FOV: 45 degrees
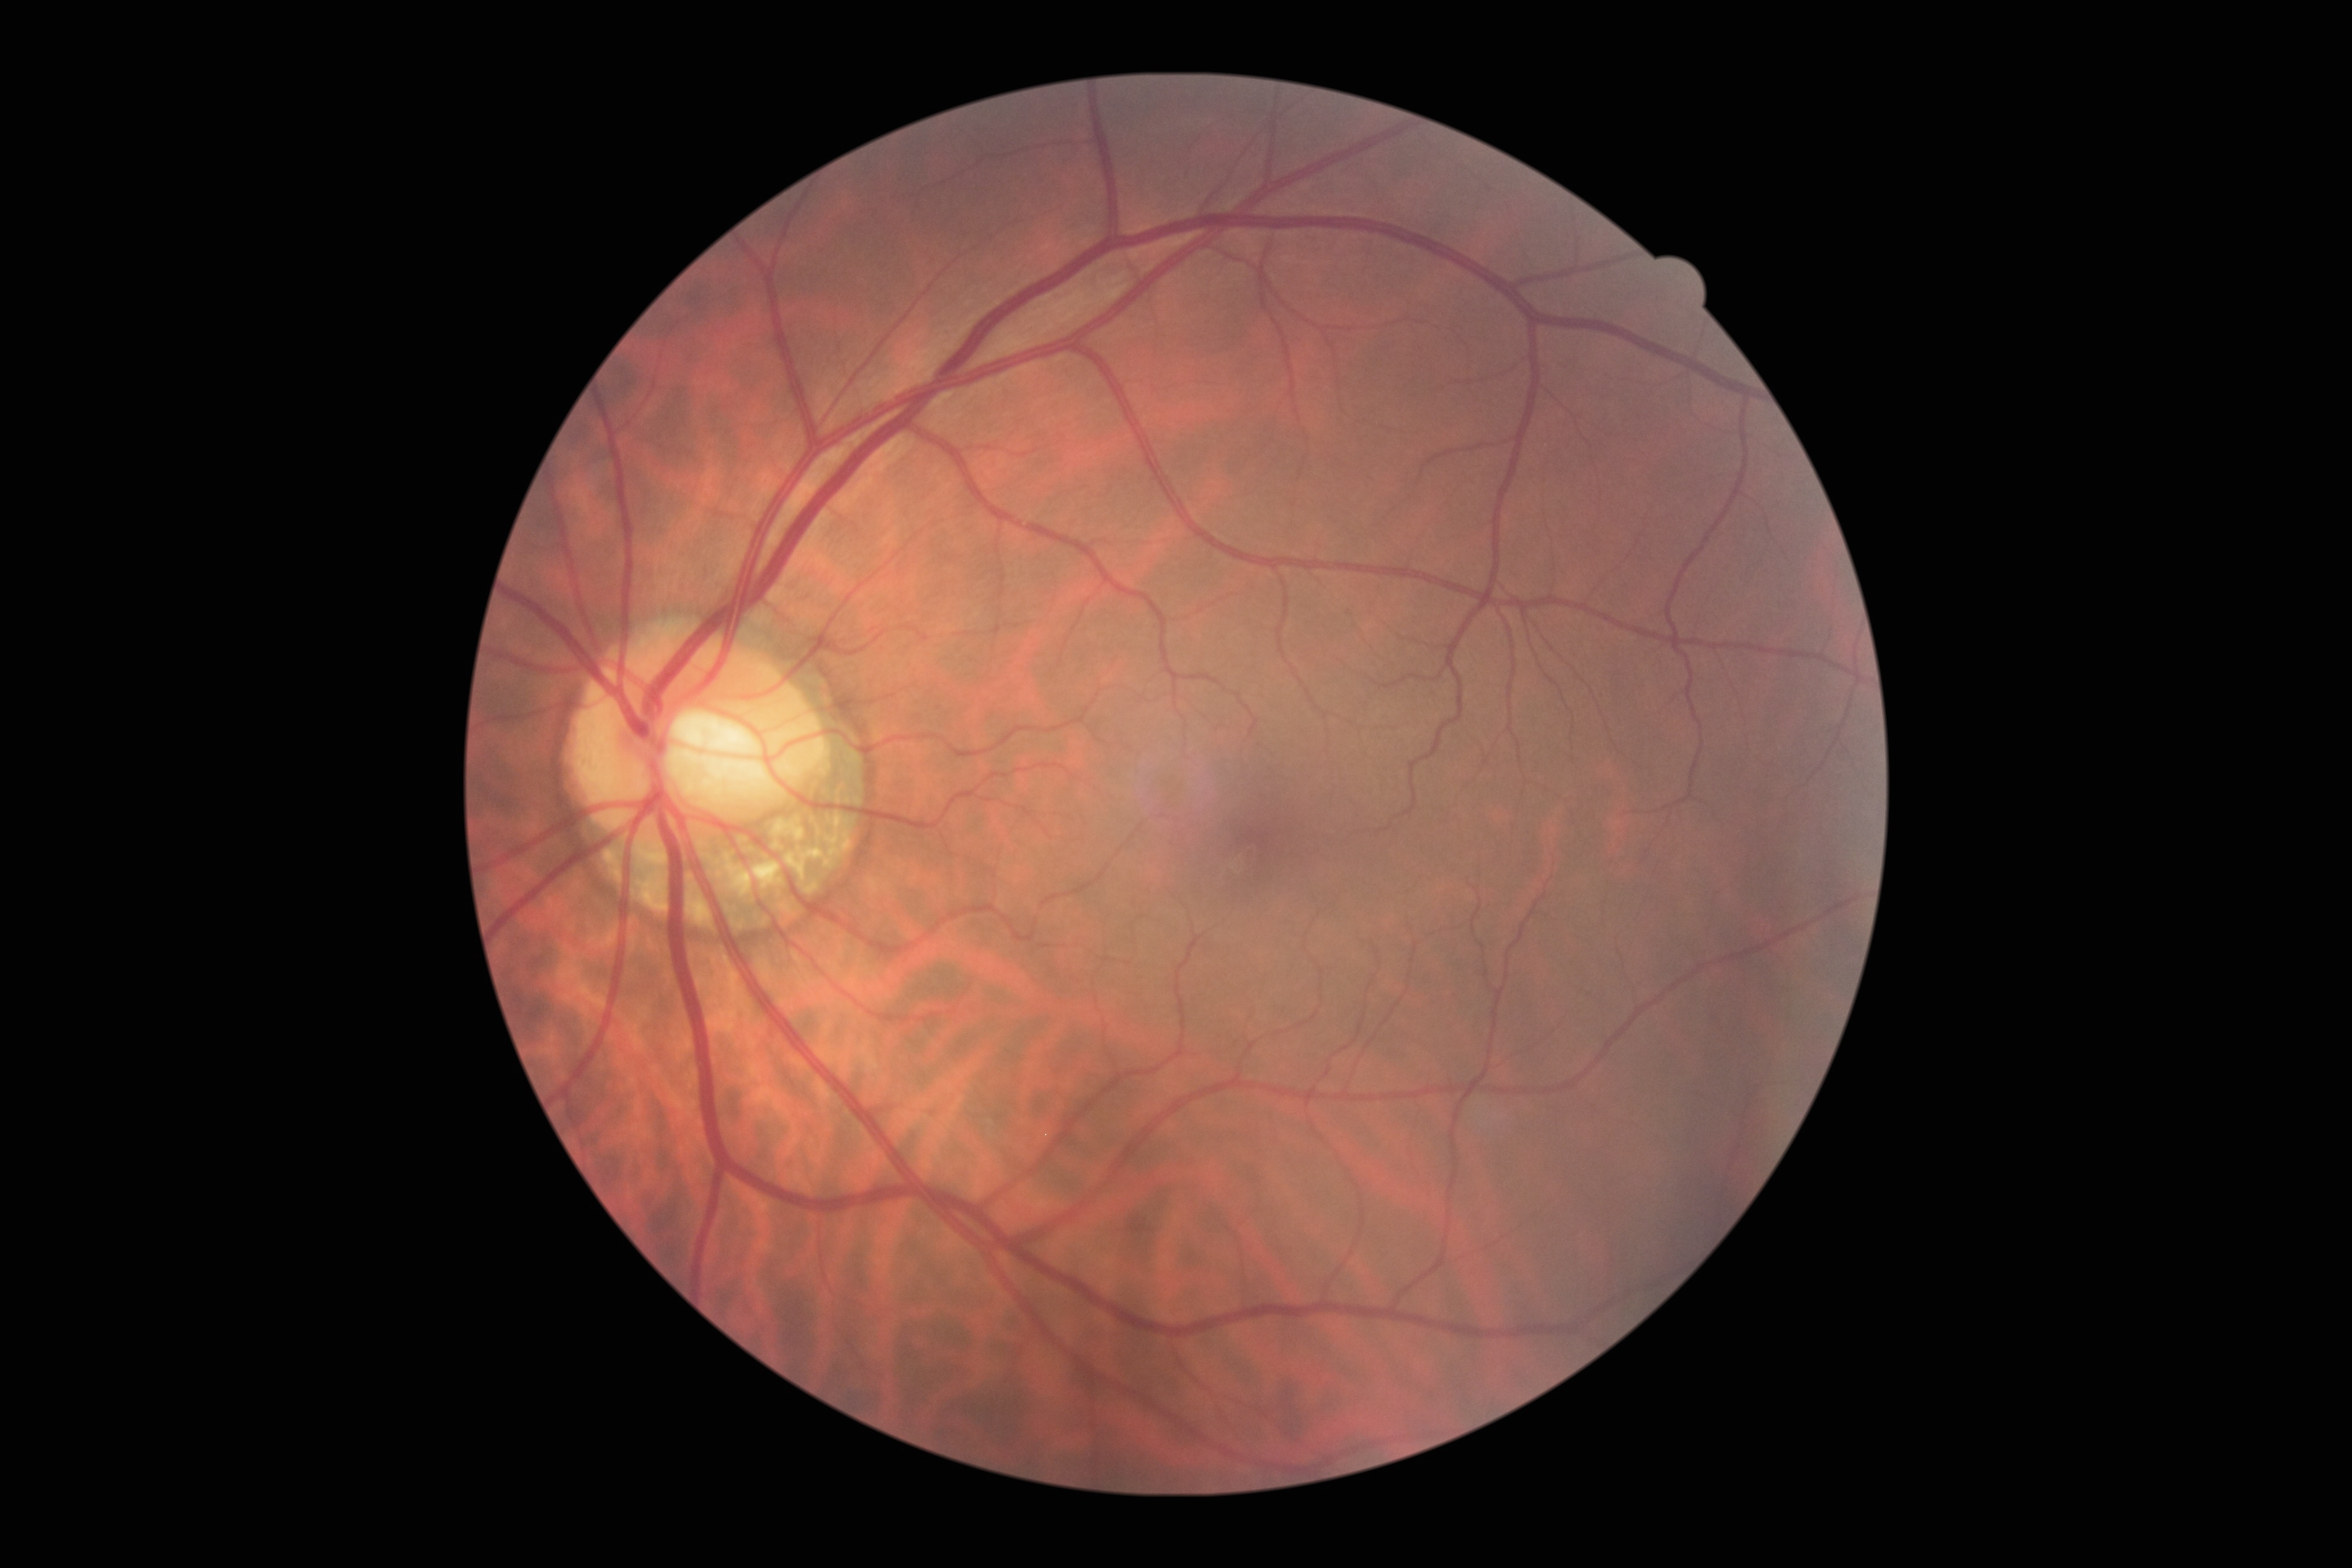
DR: grade 0 (no apparent retinopathy).